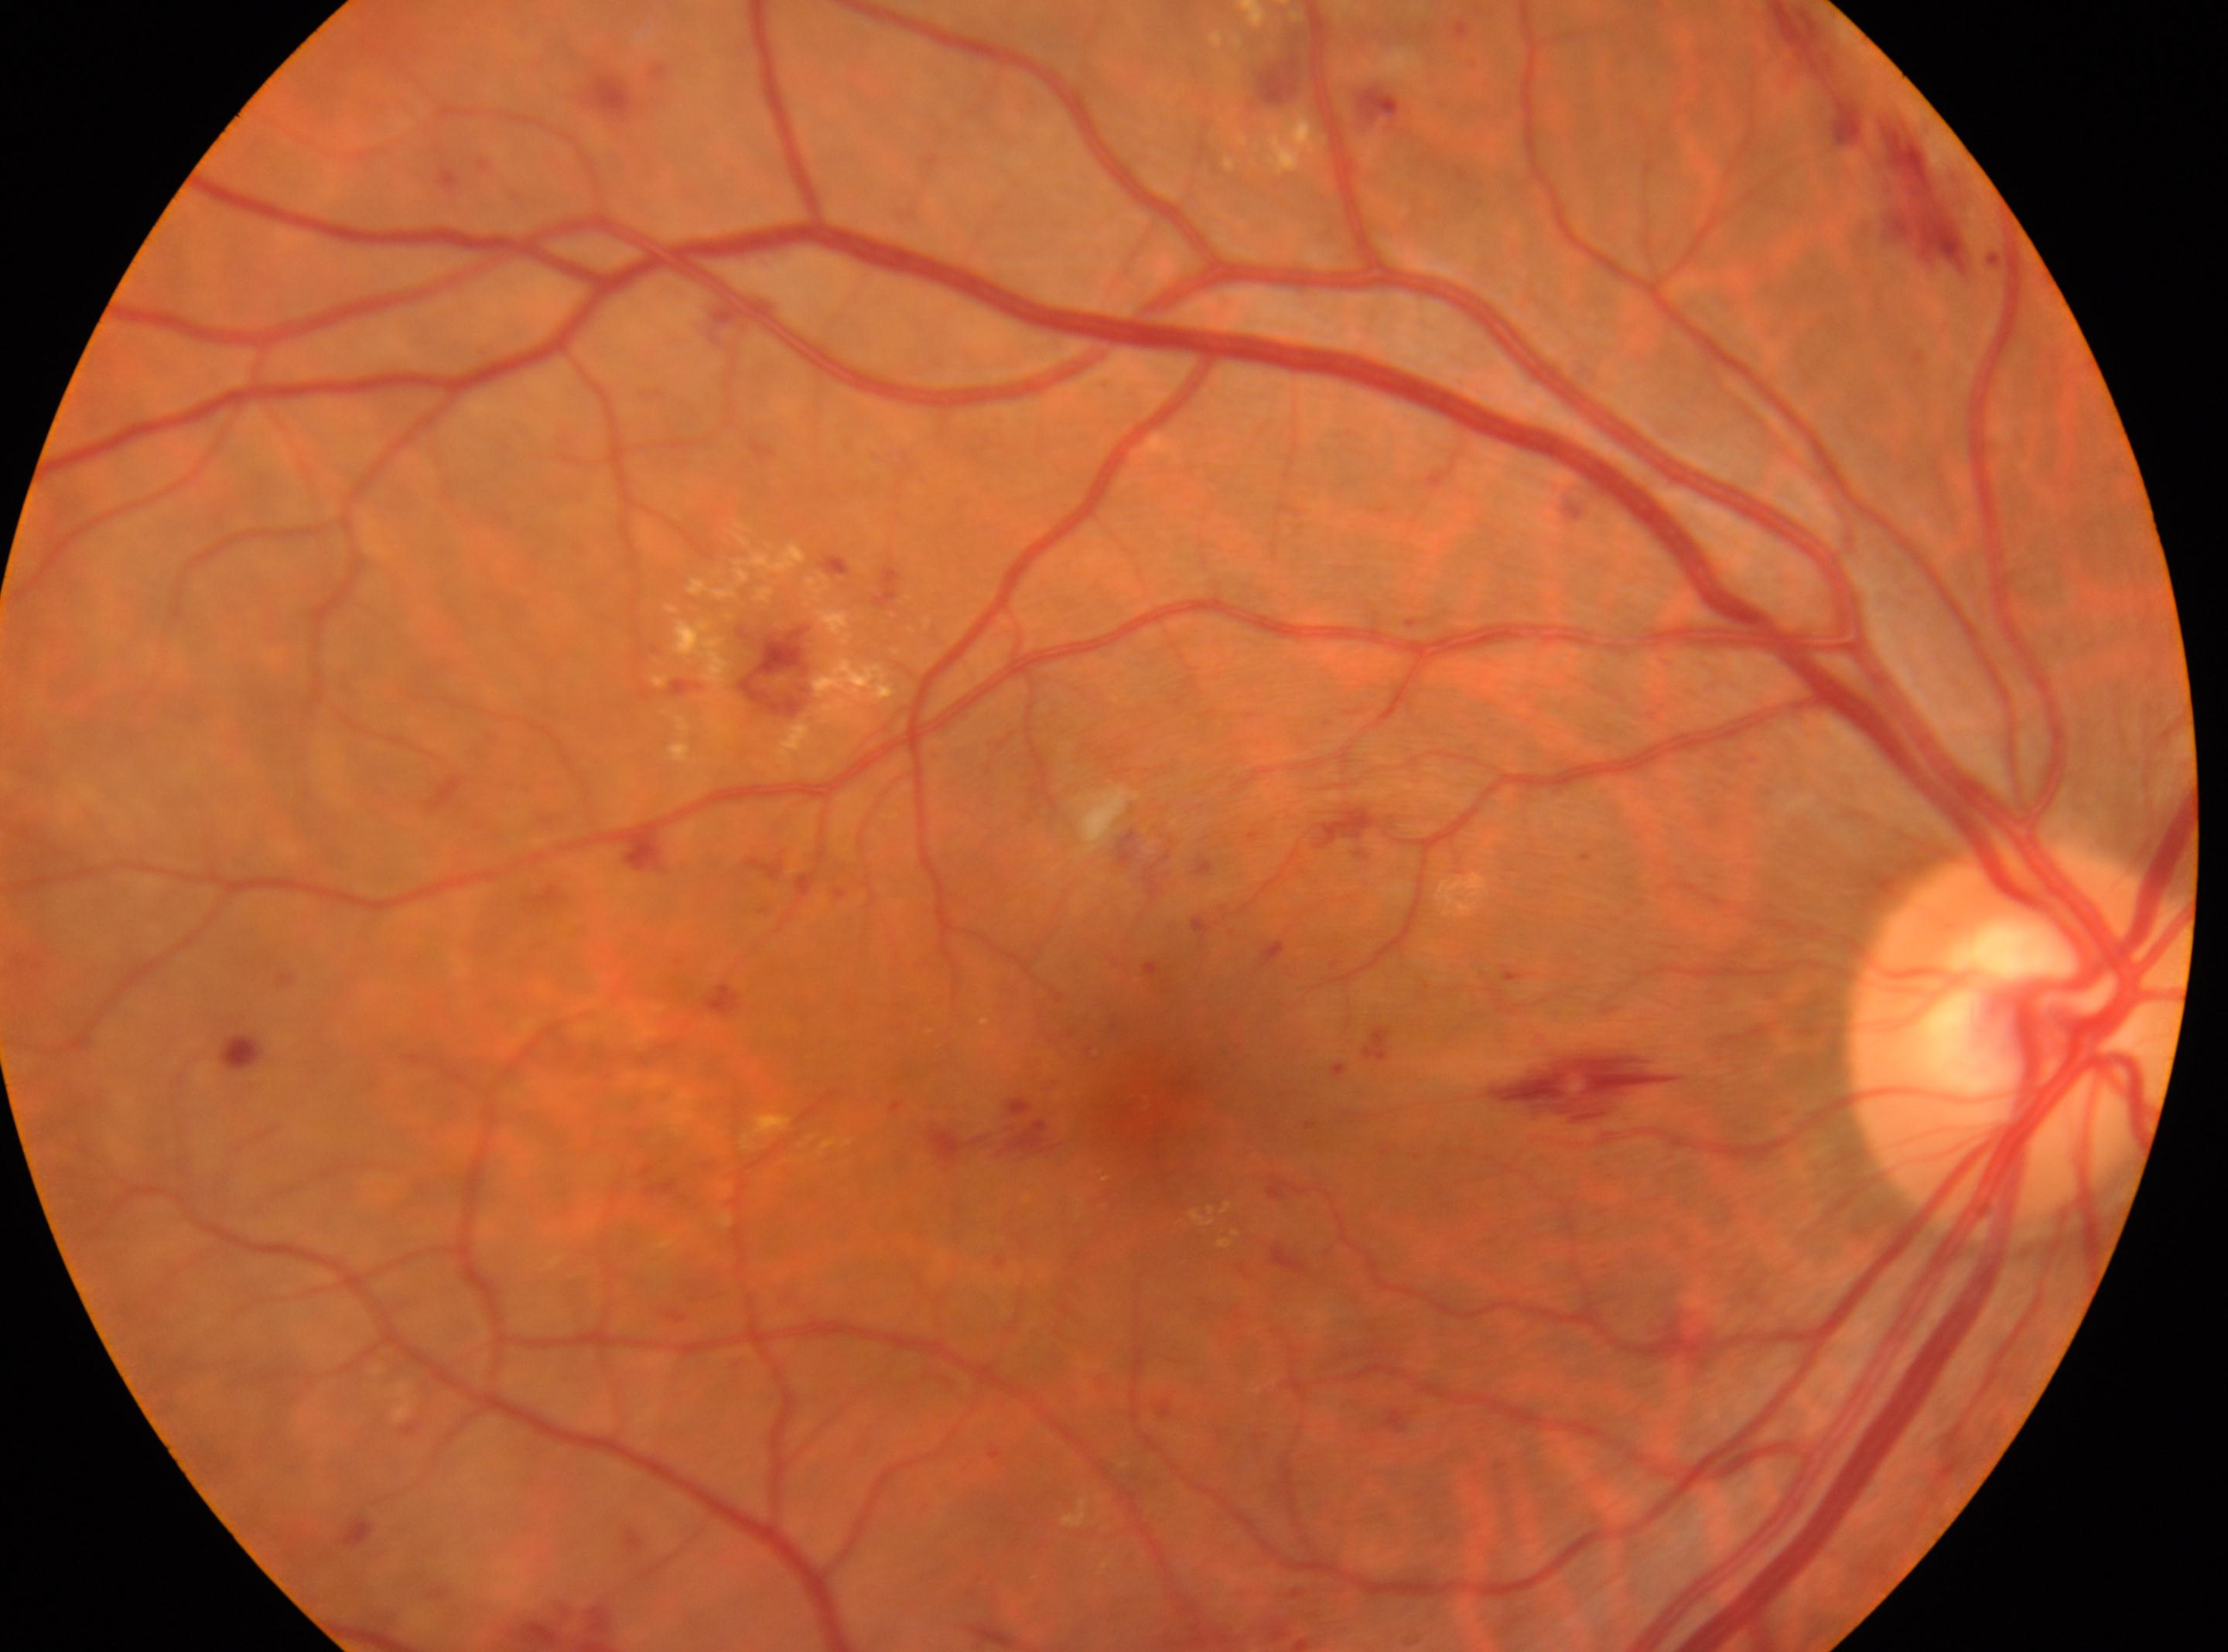
diabetic retinopathy severity: severe NPDR (grade 3)
the optic disc: (x: 2020, y: 1040)
macula center: (x: 1173, y: 1120)
laterality: right